45° FOV; 1932 by 1932 pixels — 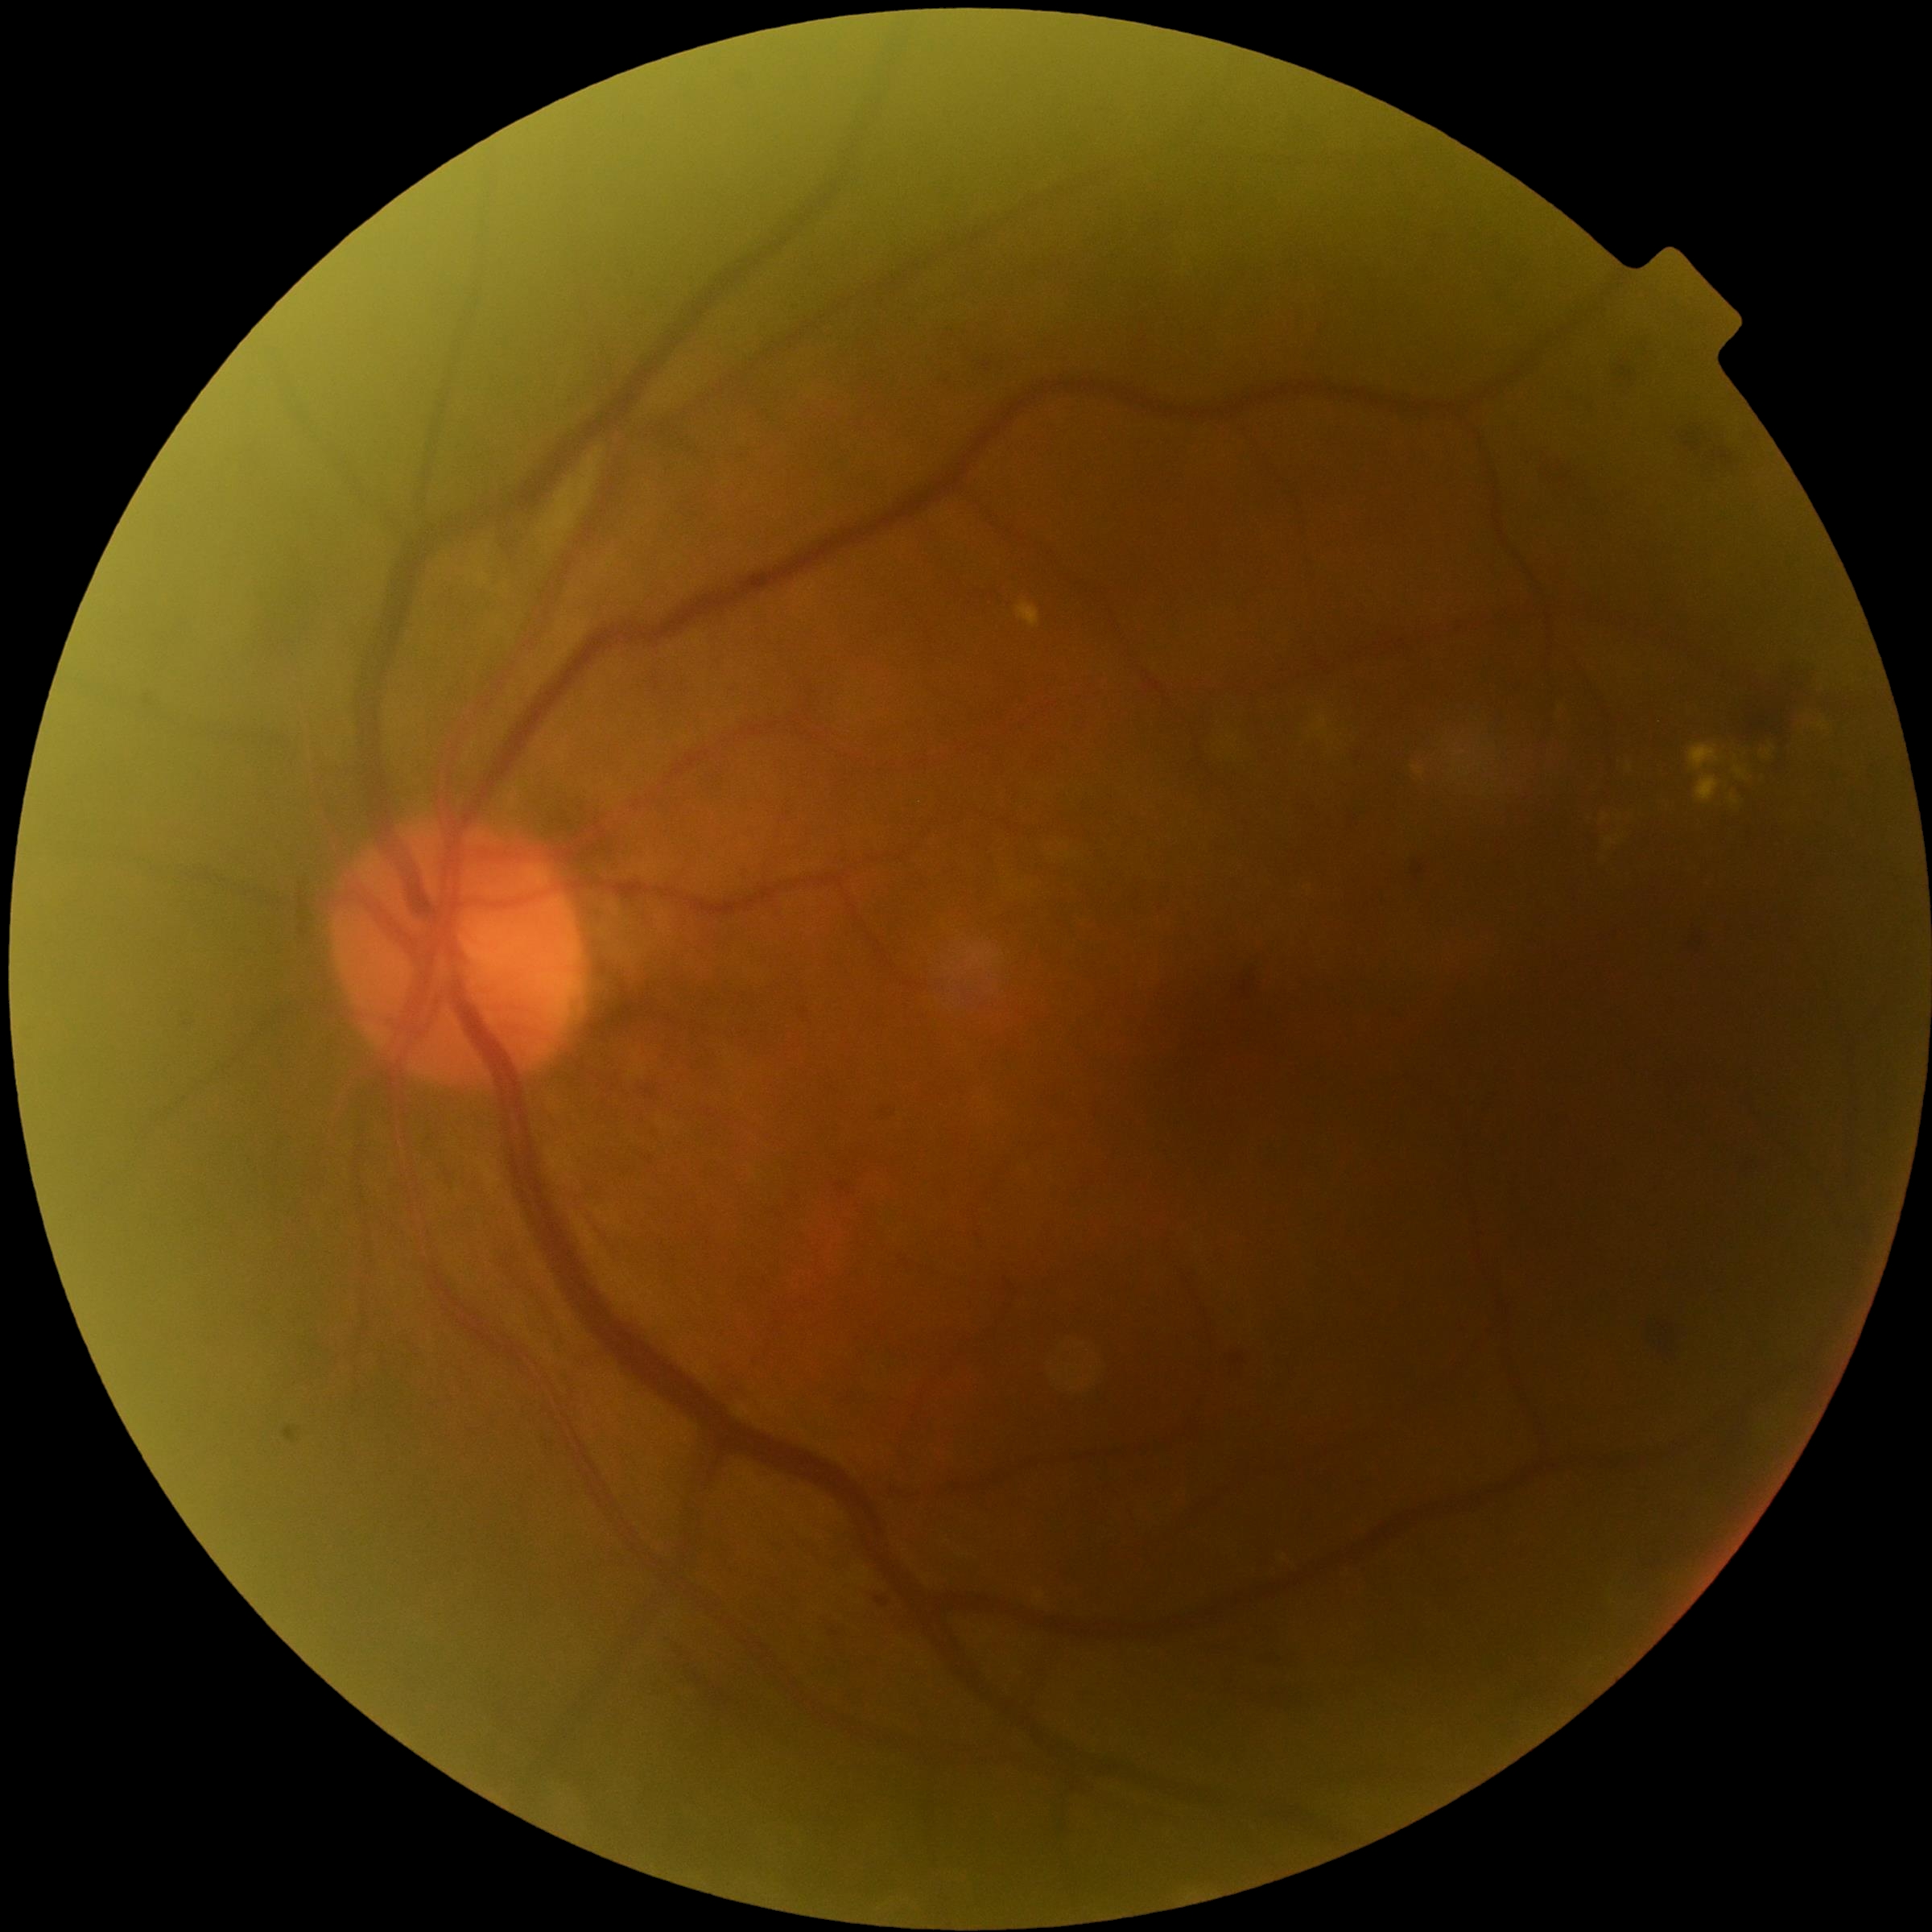

diabetic retinopathy (DR)=2/4.